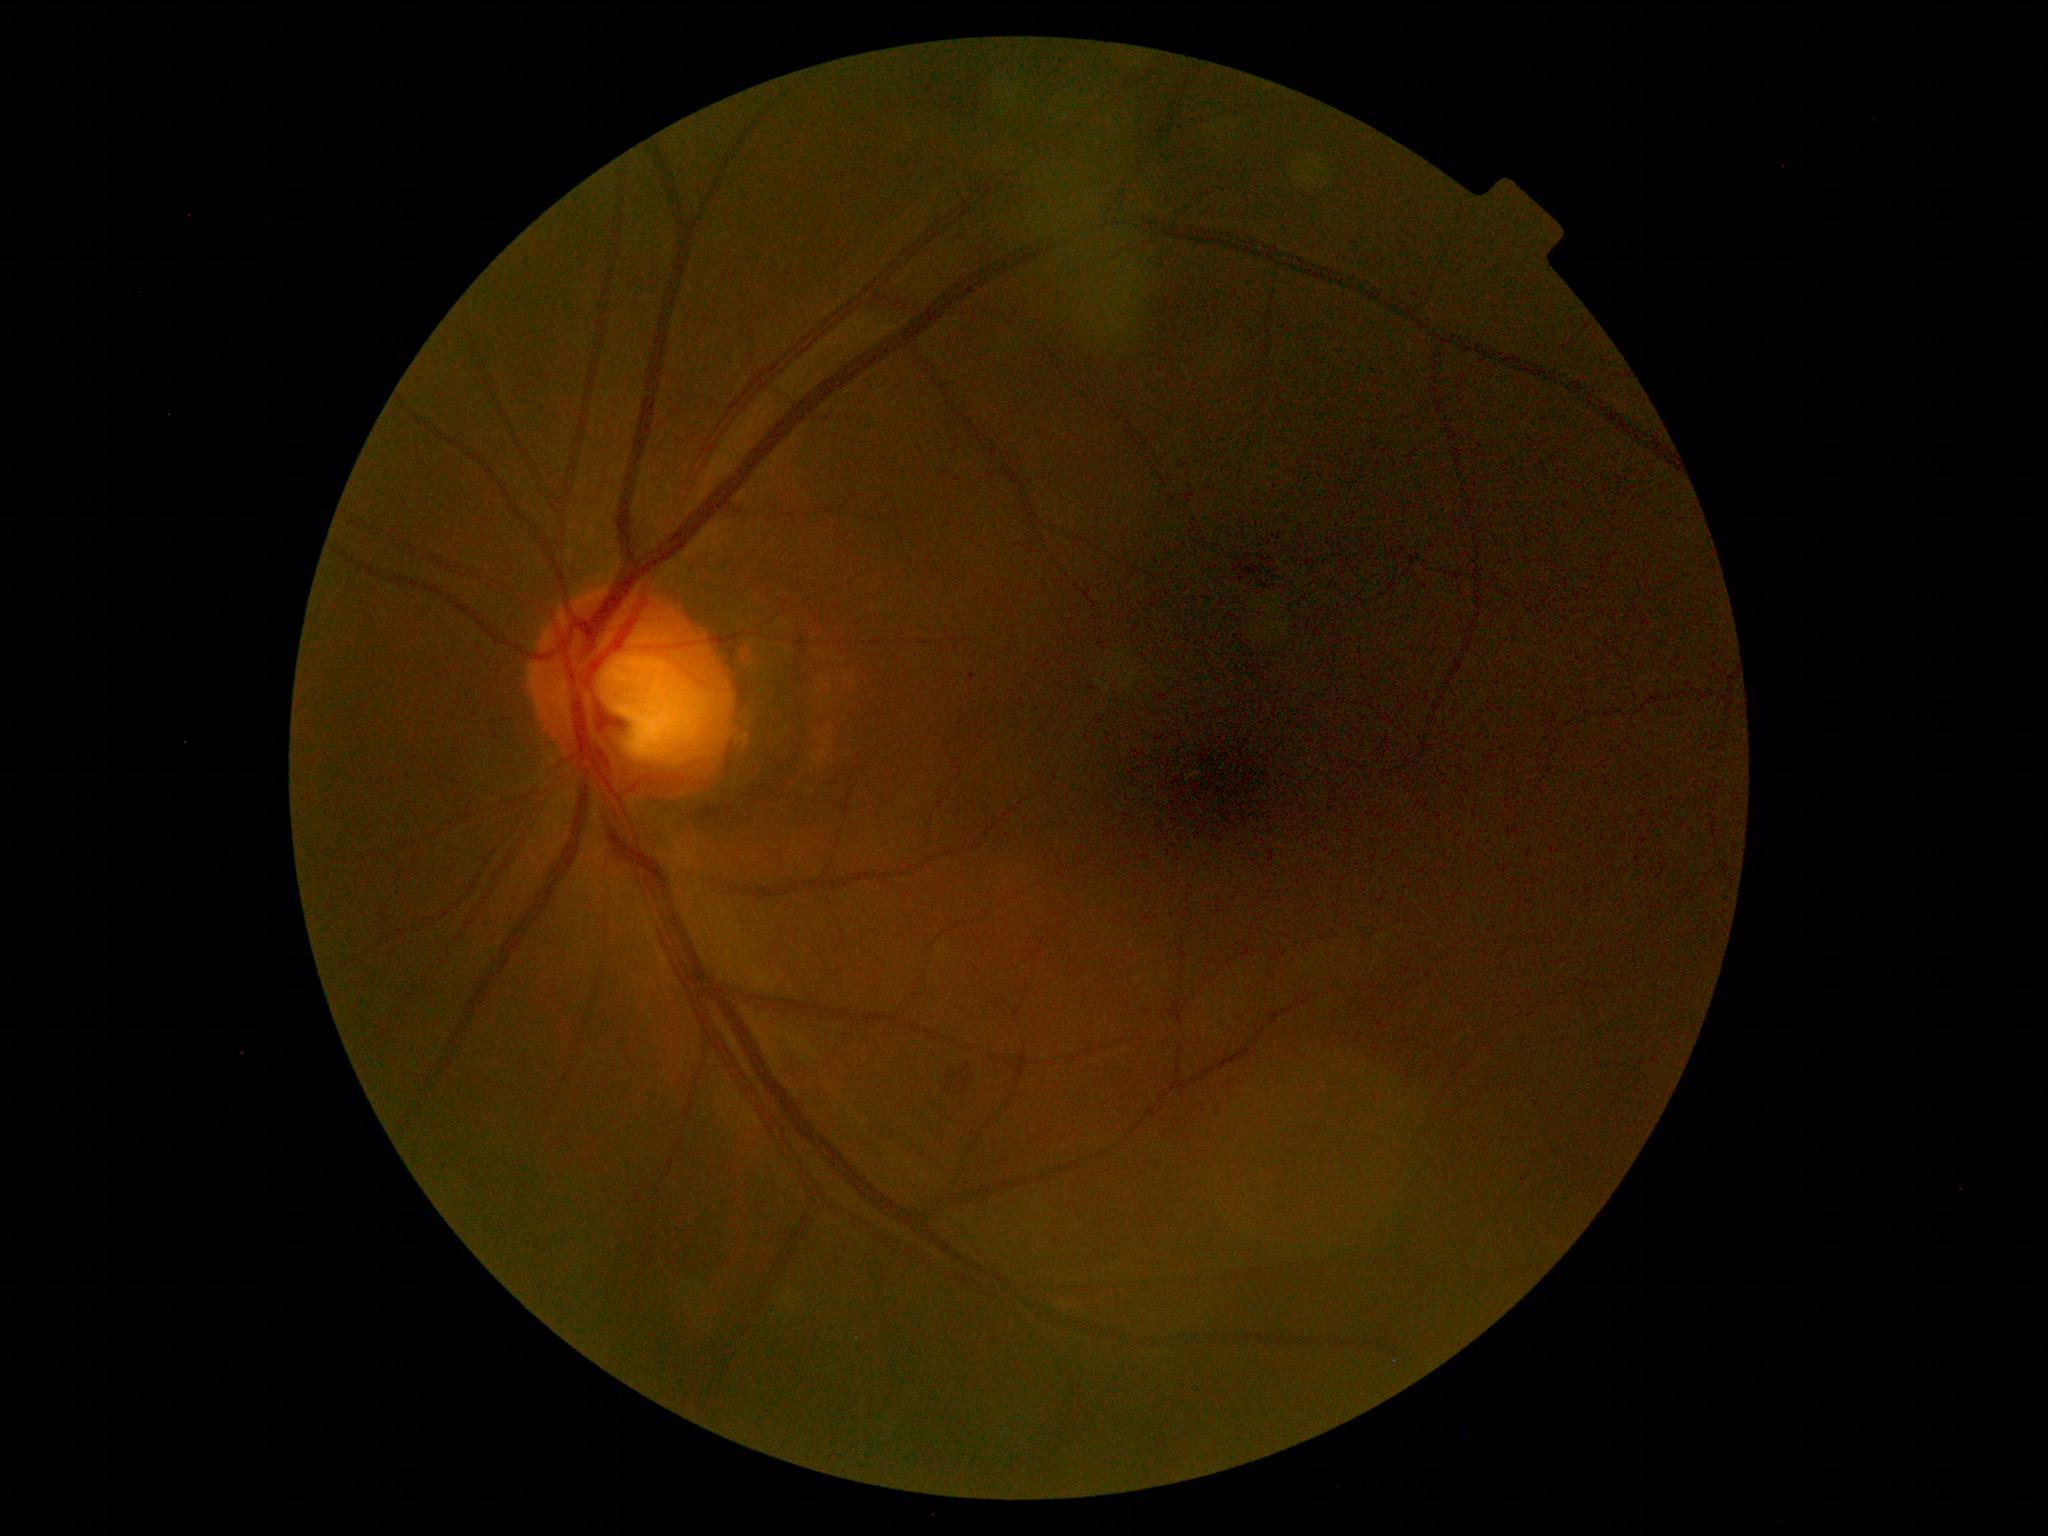
DR stage: 2.